Nonmydriatic fundus photograph · posterior pole photograph
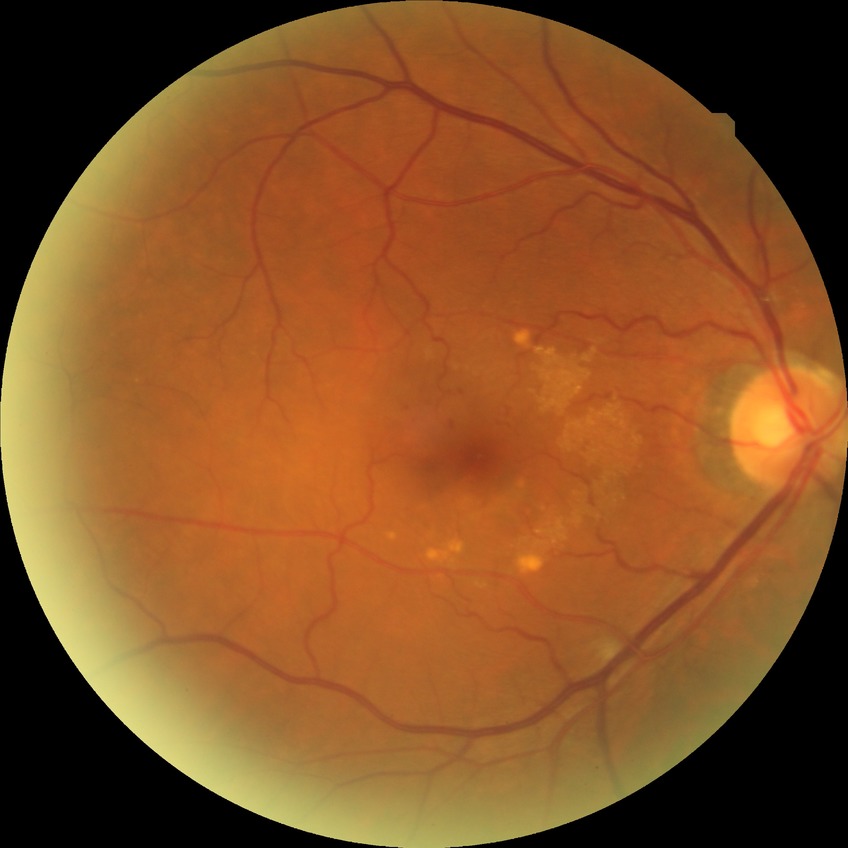
Diabetic retinopathy stage is simple diabetic retinopathy.